Nonmydriatic.
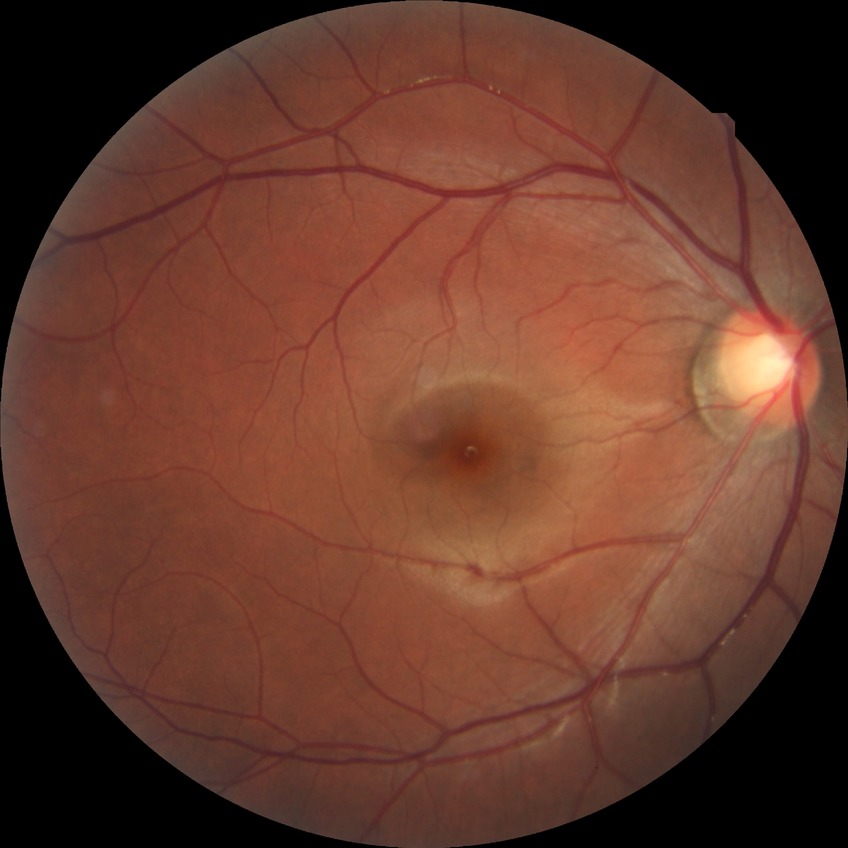

Diabetic retinopathy stage is no diabetic retinopathy.